Without pupil dilation — 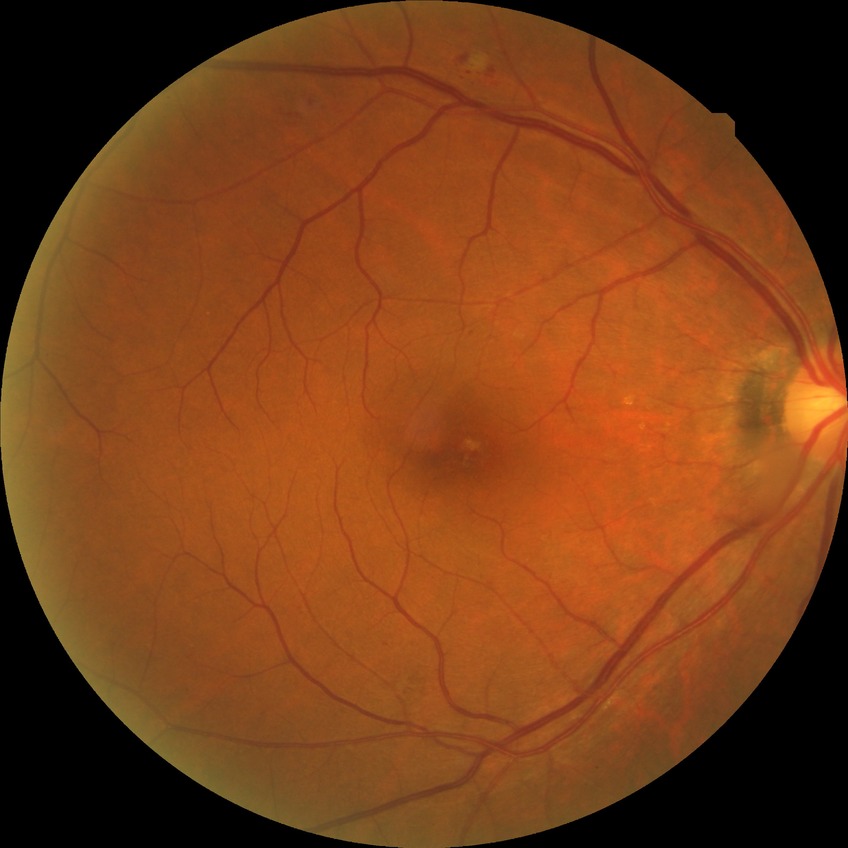

Diabetic retinopathy severity: no diabetic retinopathy.